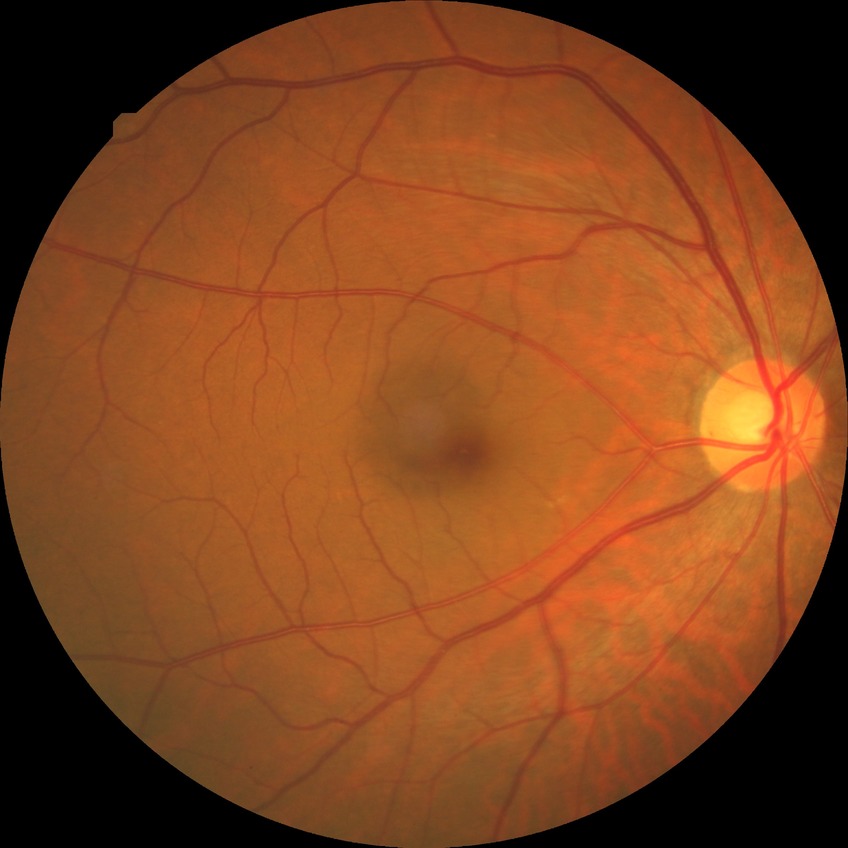
Retinopathy grade: no diabetic retinopathy.